Image size 1924x1556: 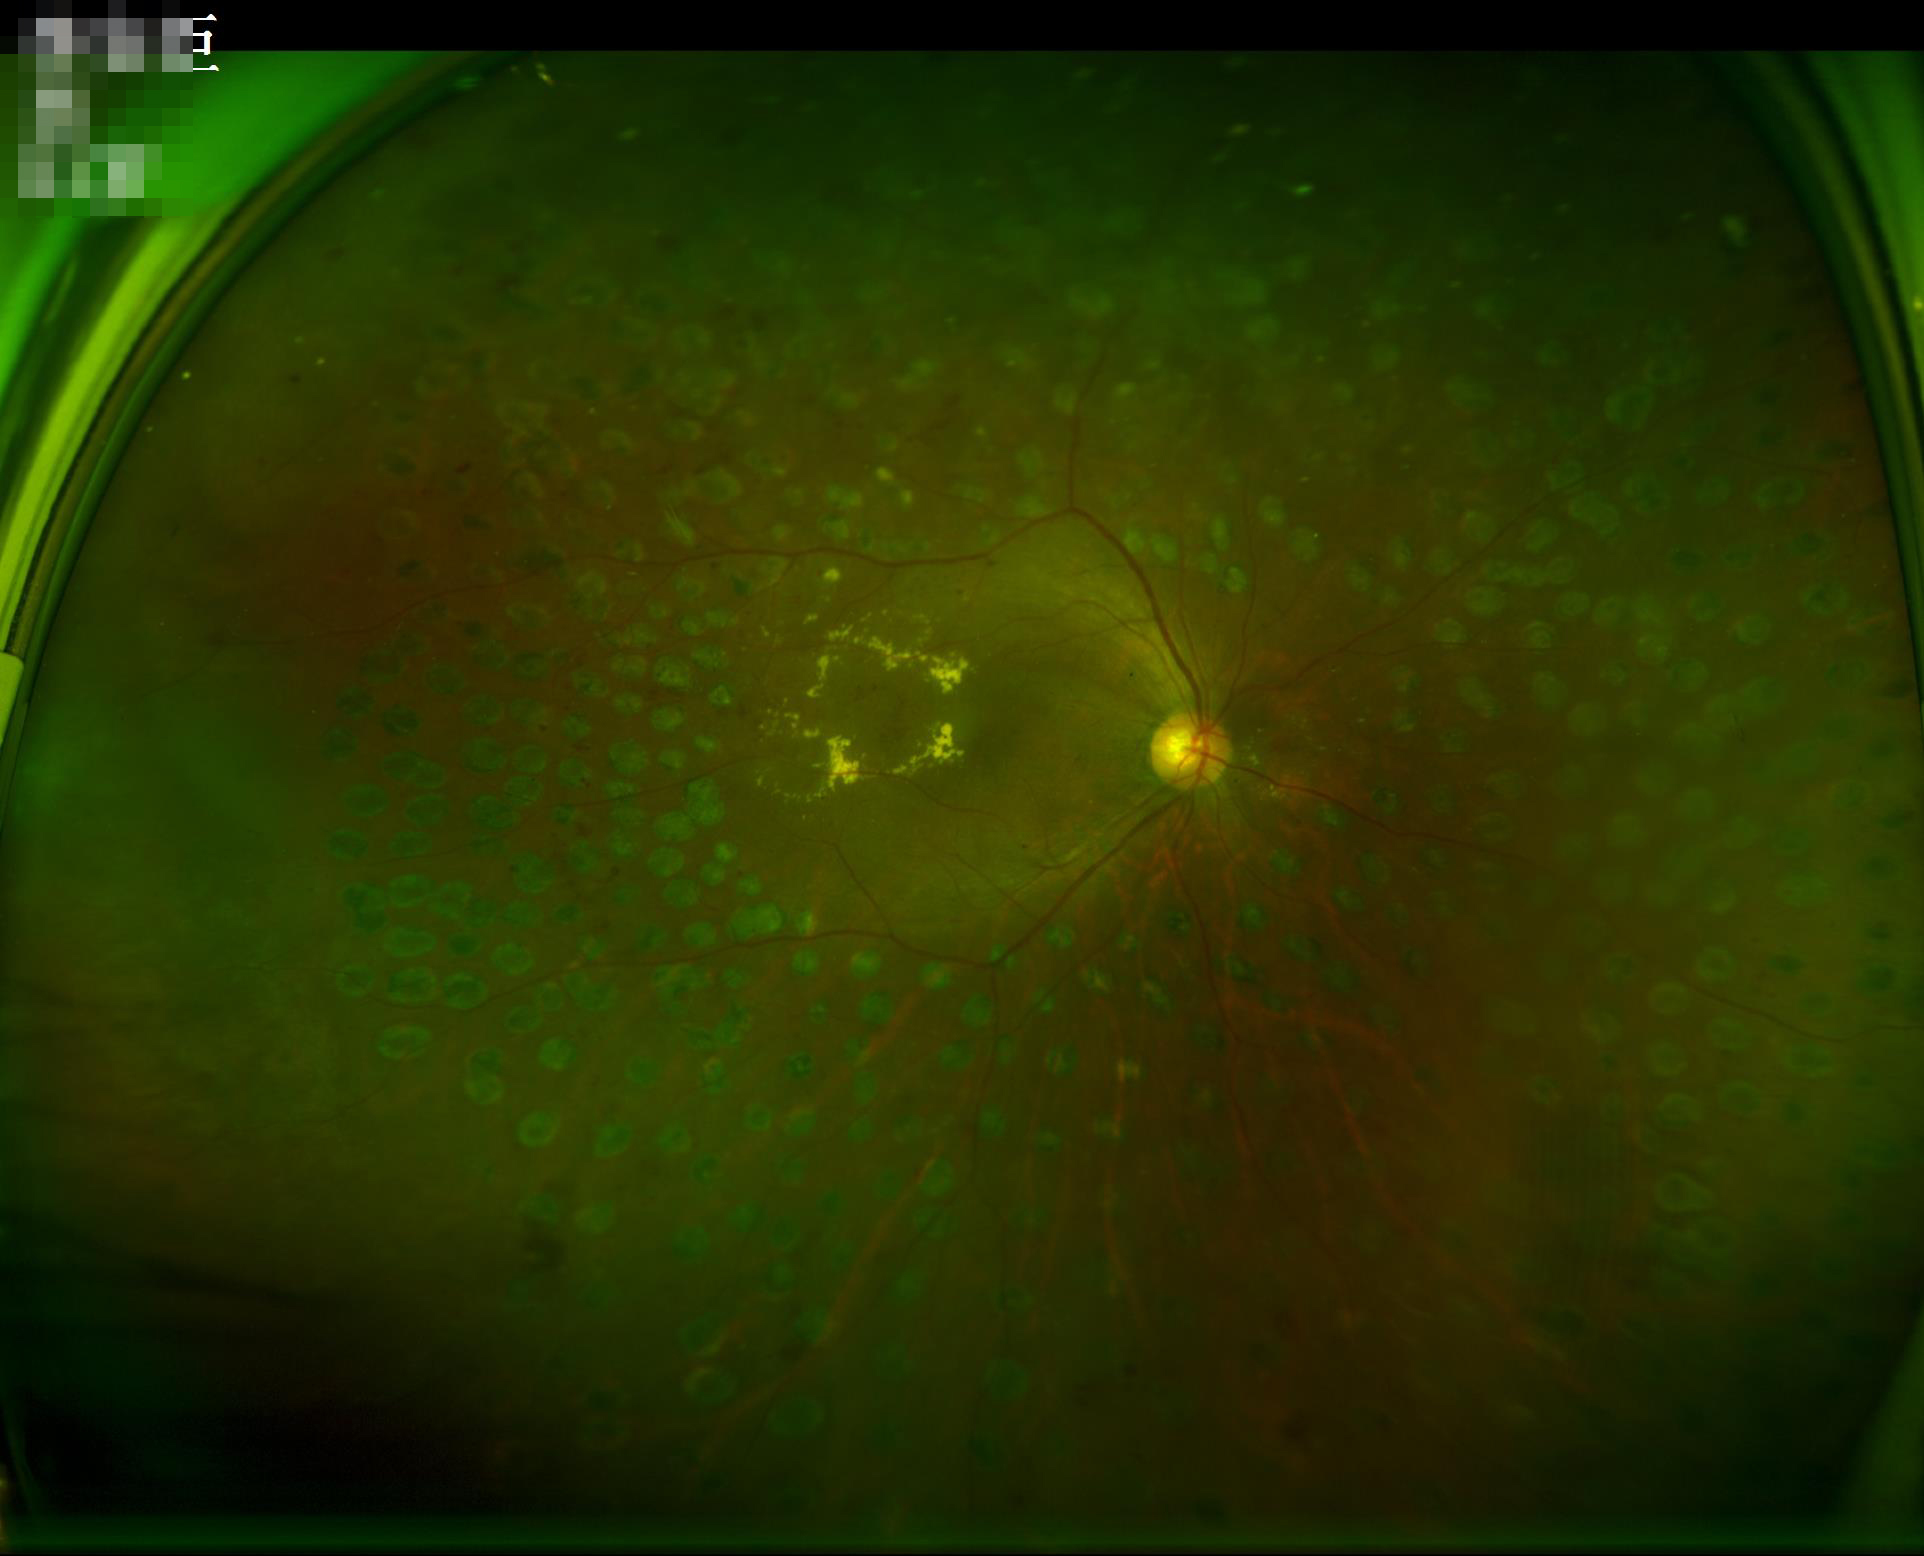

Contrast is good. Image is sharp throughout the field. Illumination is uneven.